2352 x 1568 pixels: 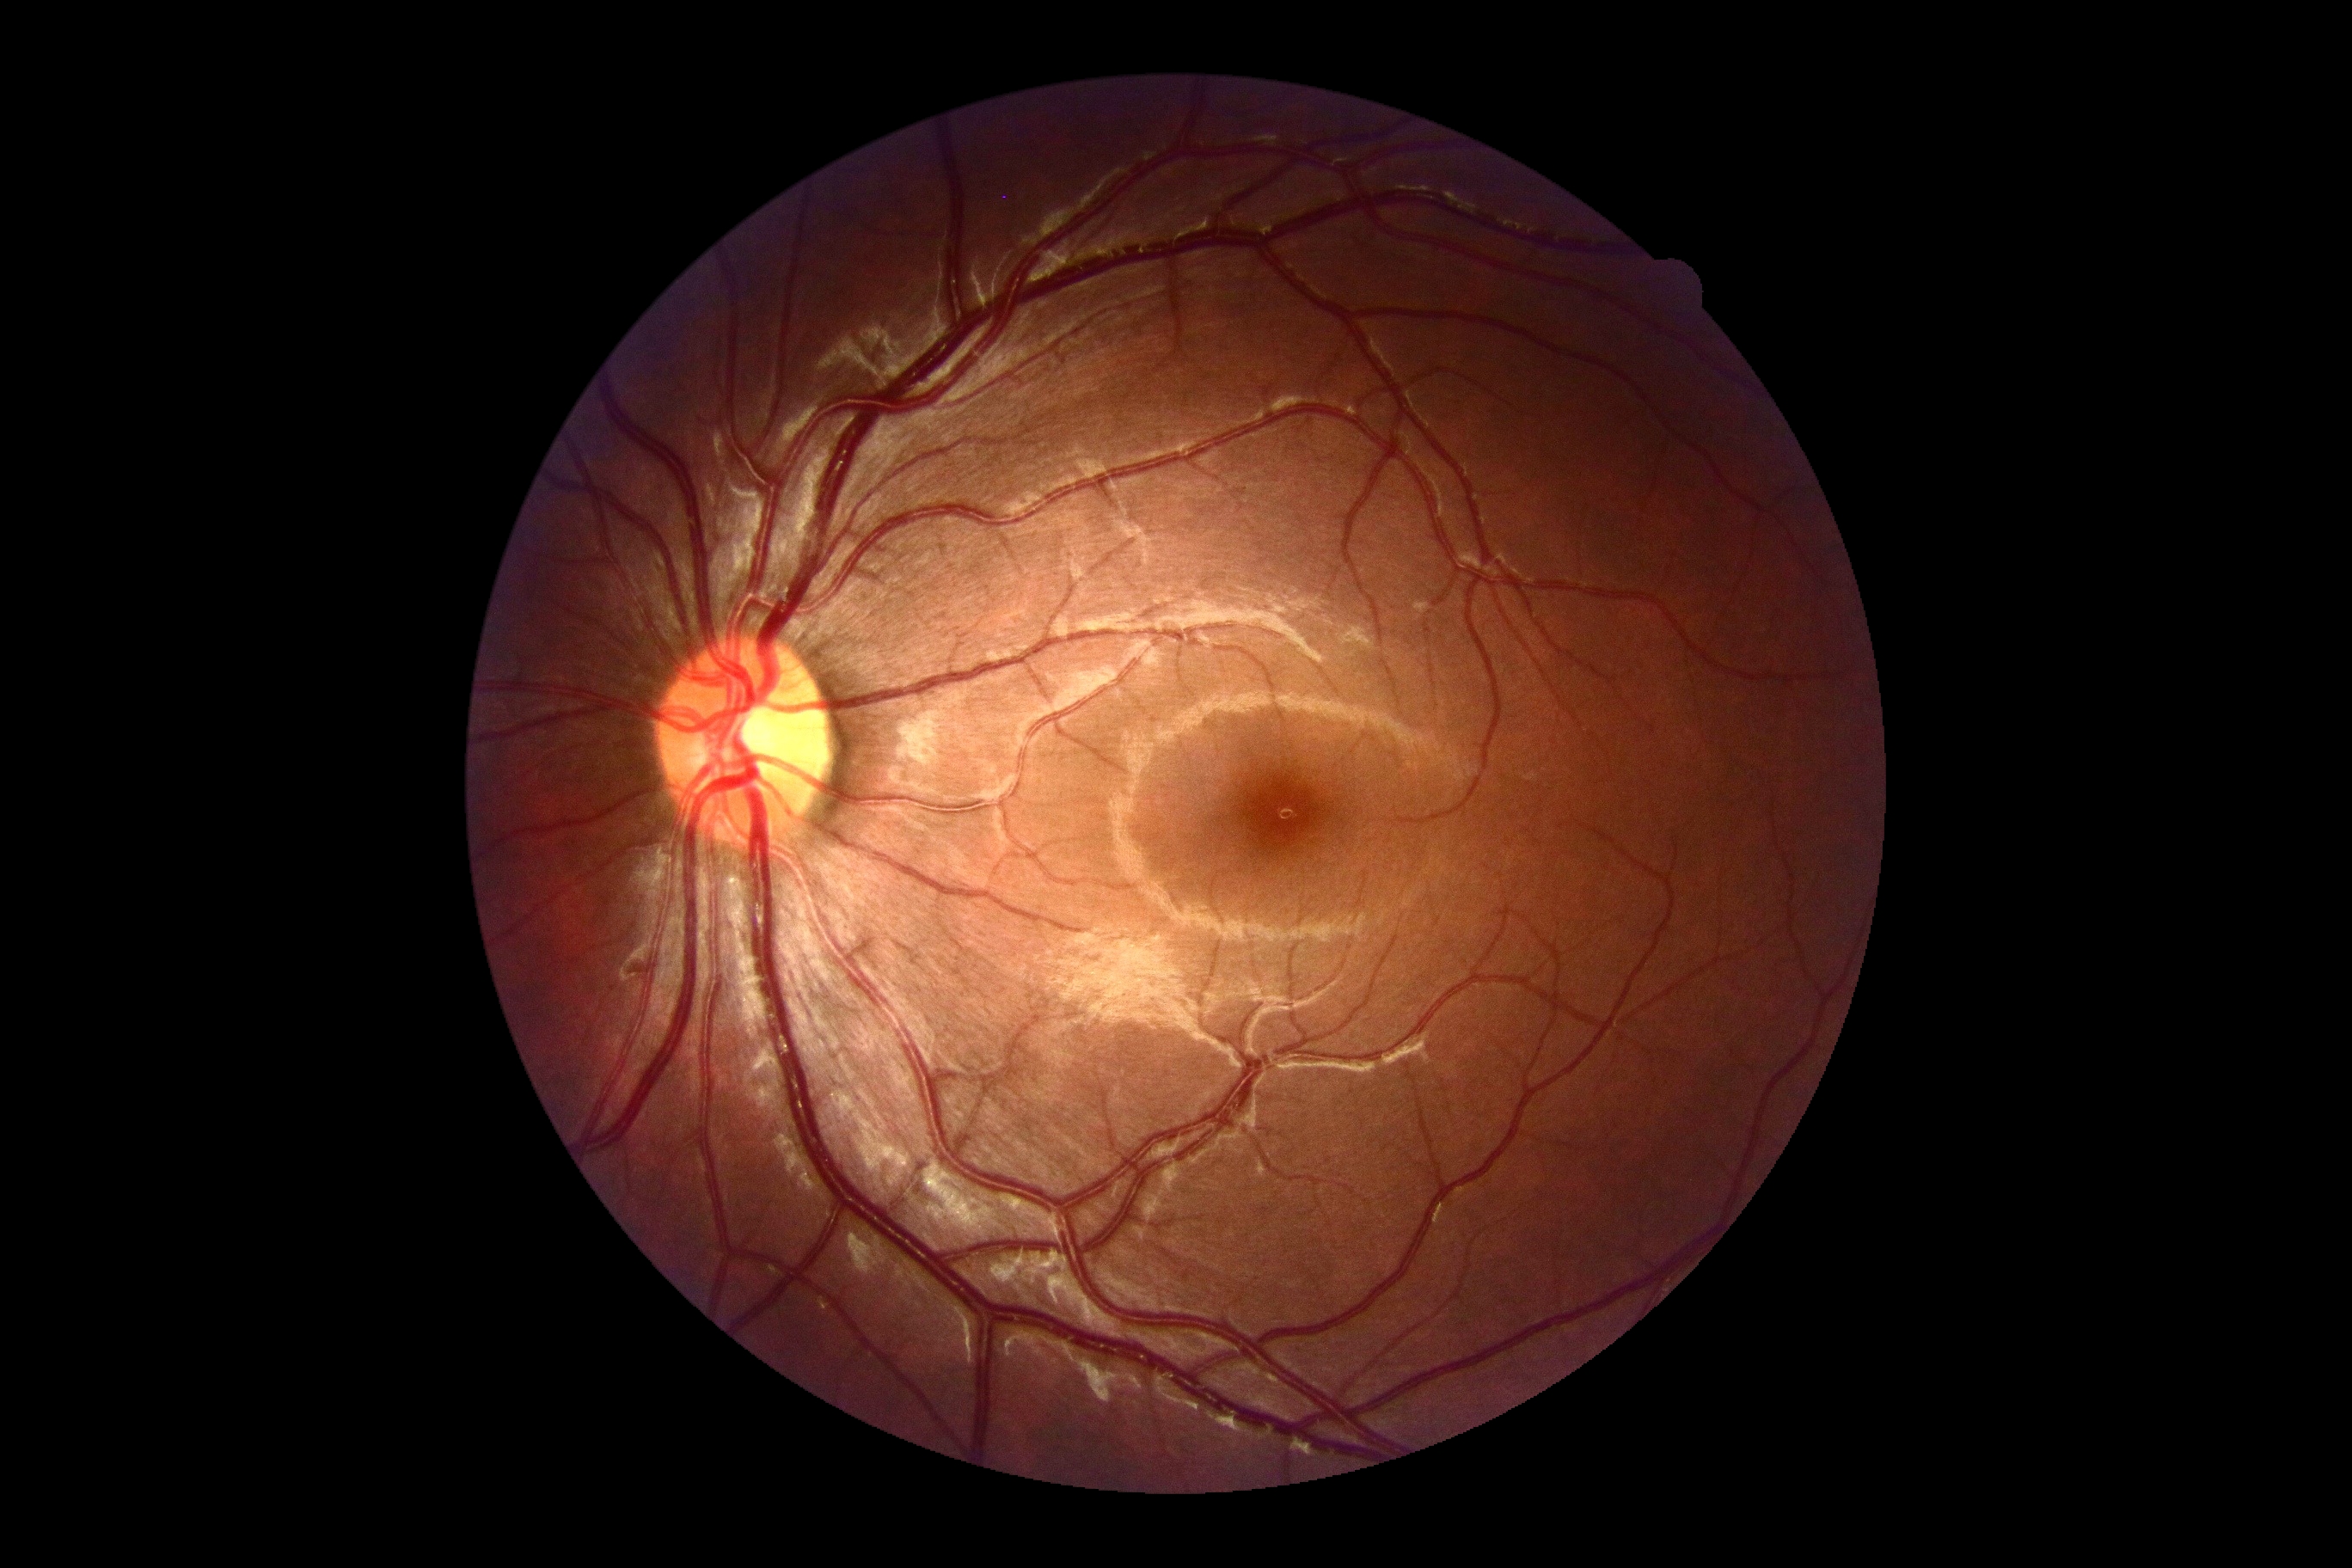   dr_grade: 0